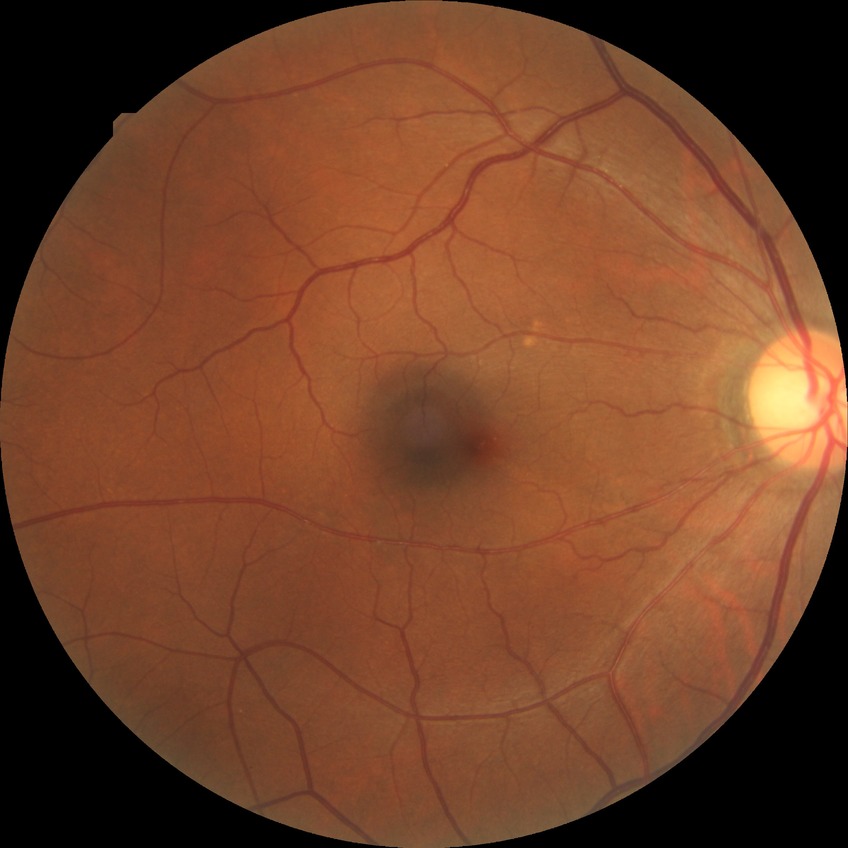

Diabetic retinopathy severity: simple diabetic retinopathy.